Infant wide-field fundus photograph.
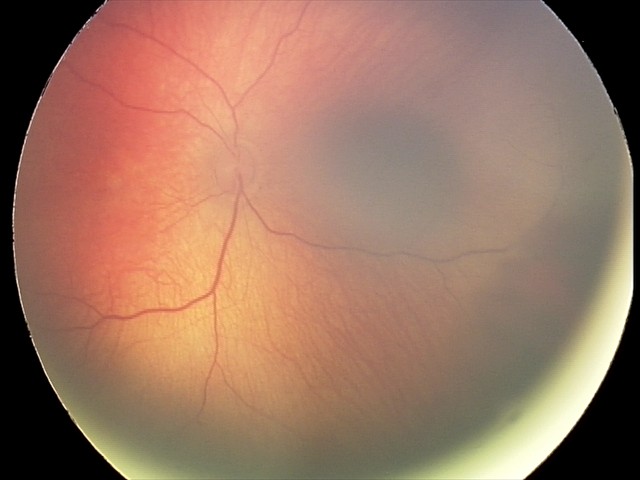 Finding = retinal hemorrhages.